640 by 480 pixels; infant wide-field retinal image.
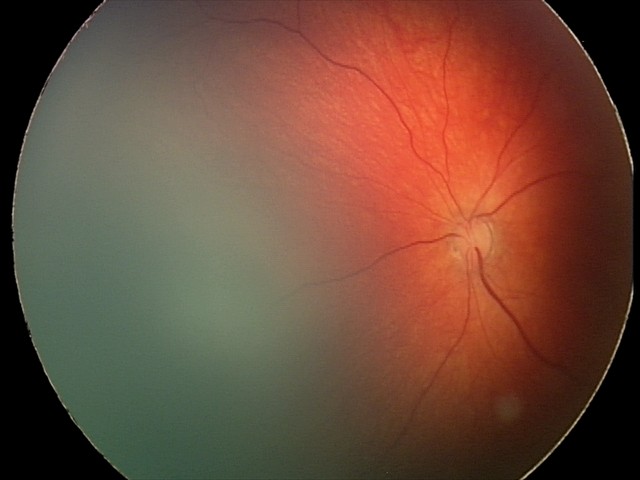

Screening examination consistent with retinal hemorrhages.